Non-mydriatic acquisition: 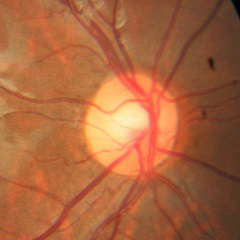

Findings consistent with no glaucomatous optic neuropathy.